Acquired with a Remidio Fundus on Phone (FOP) camera. Color fundus photograph
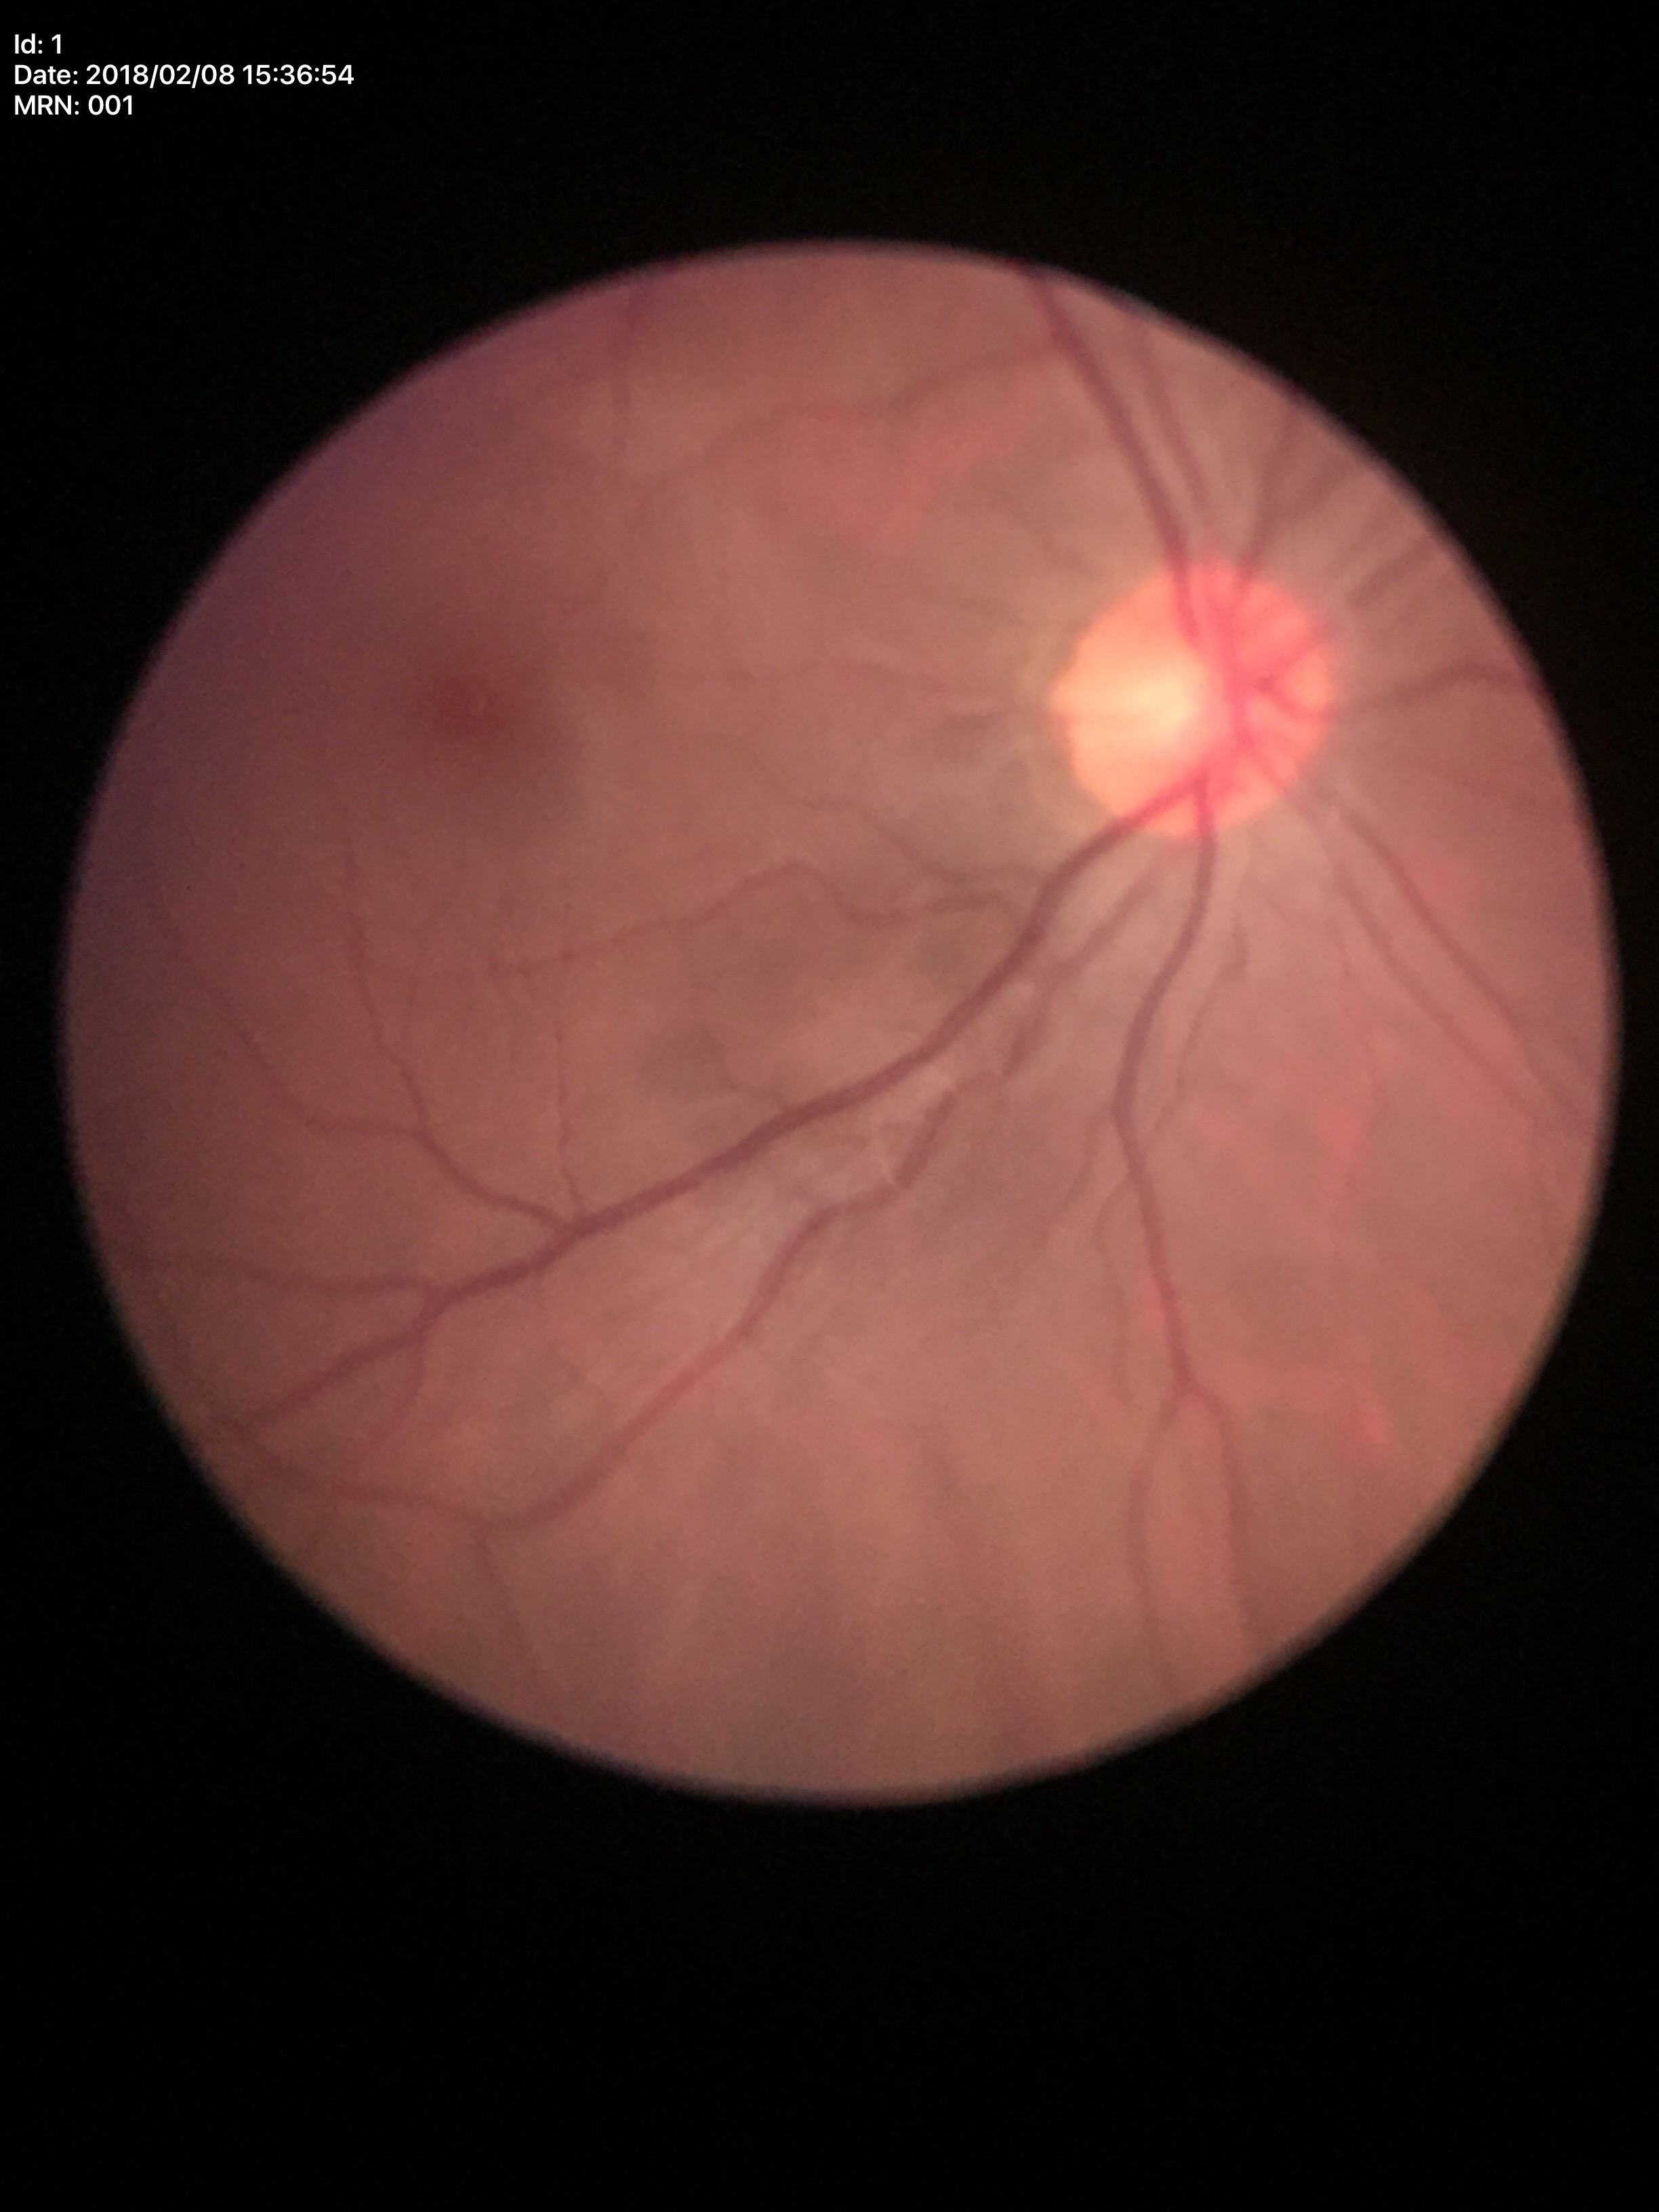 – vertical cup-disc ratio: 0.48
– Glaucoma assessment: negative